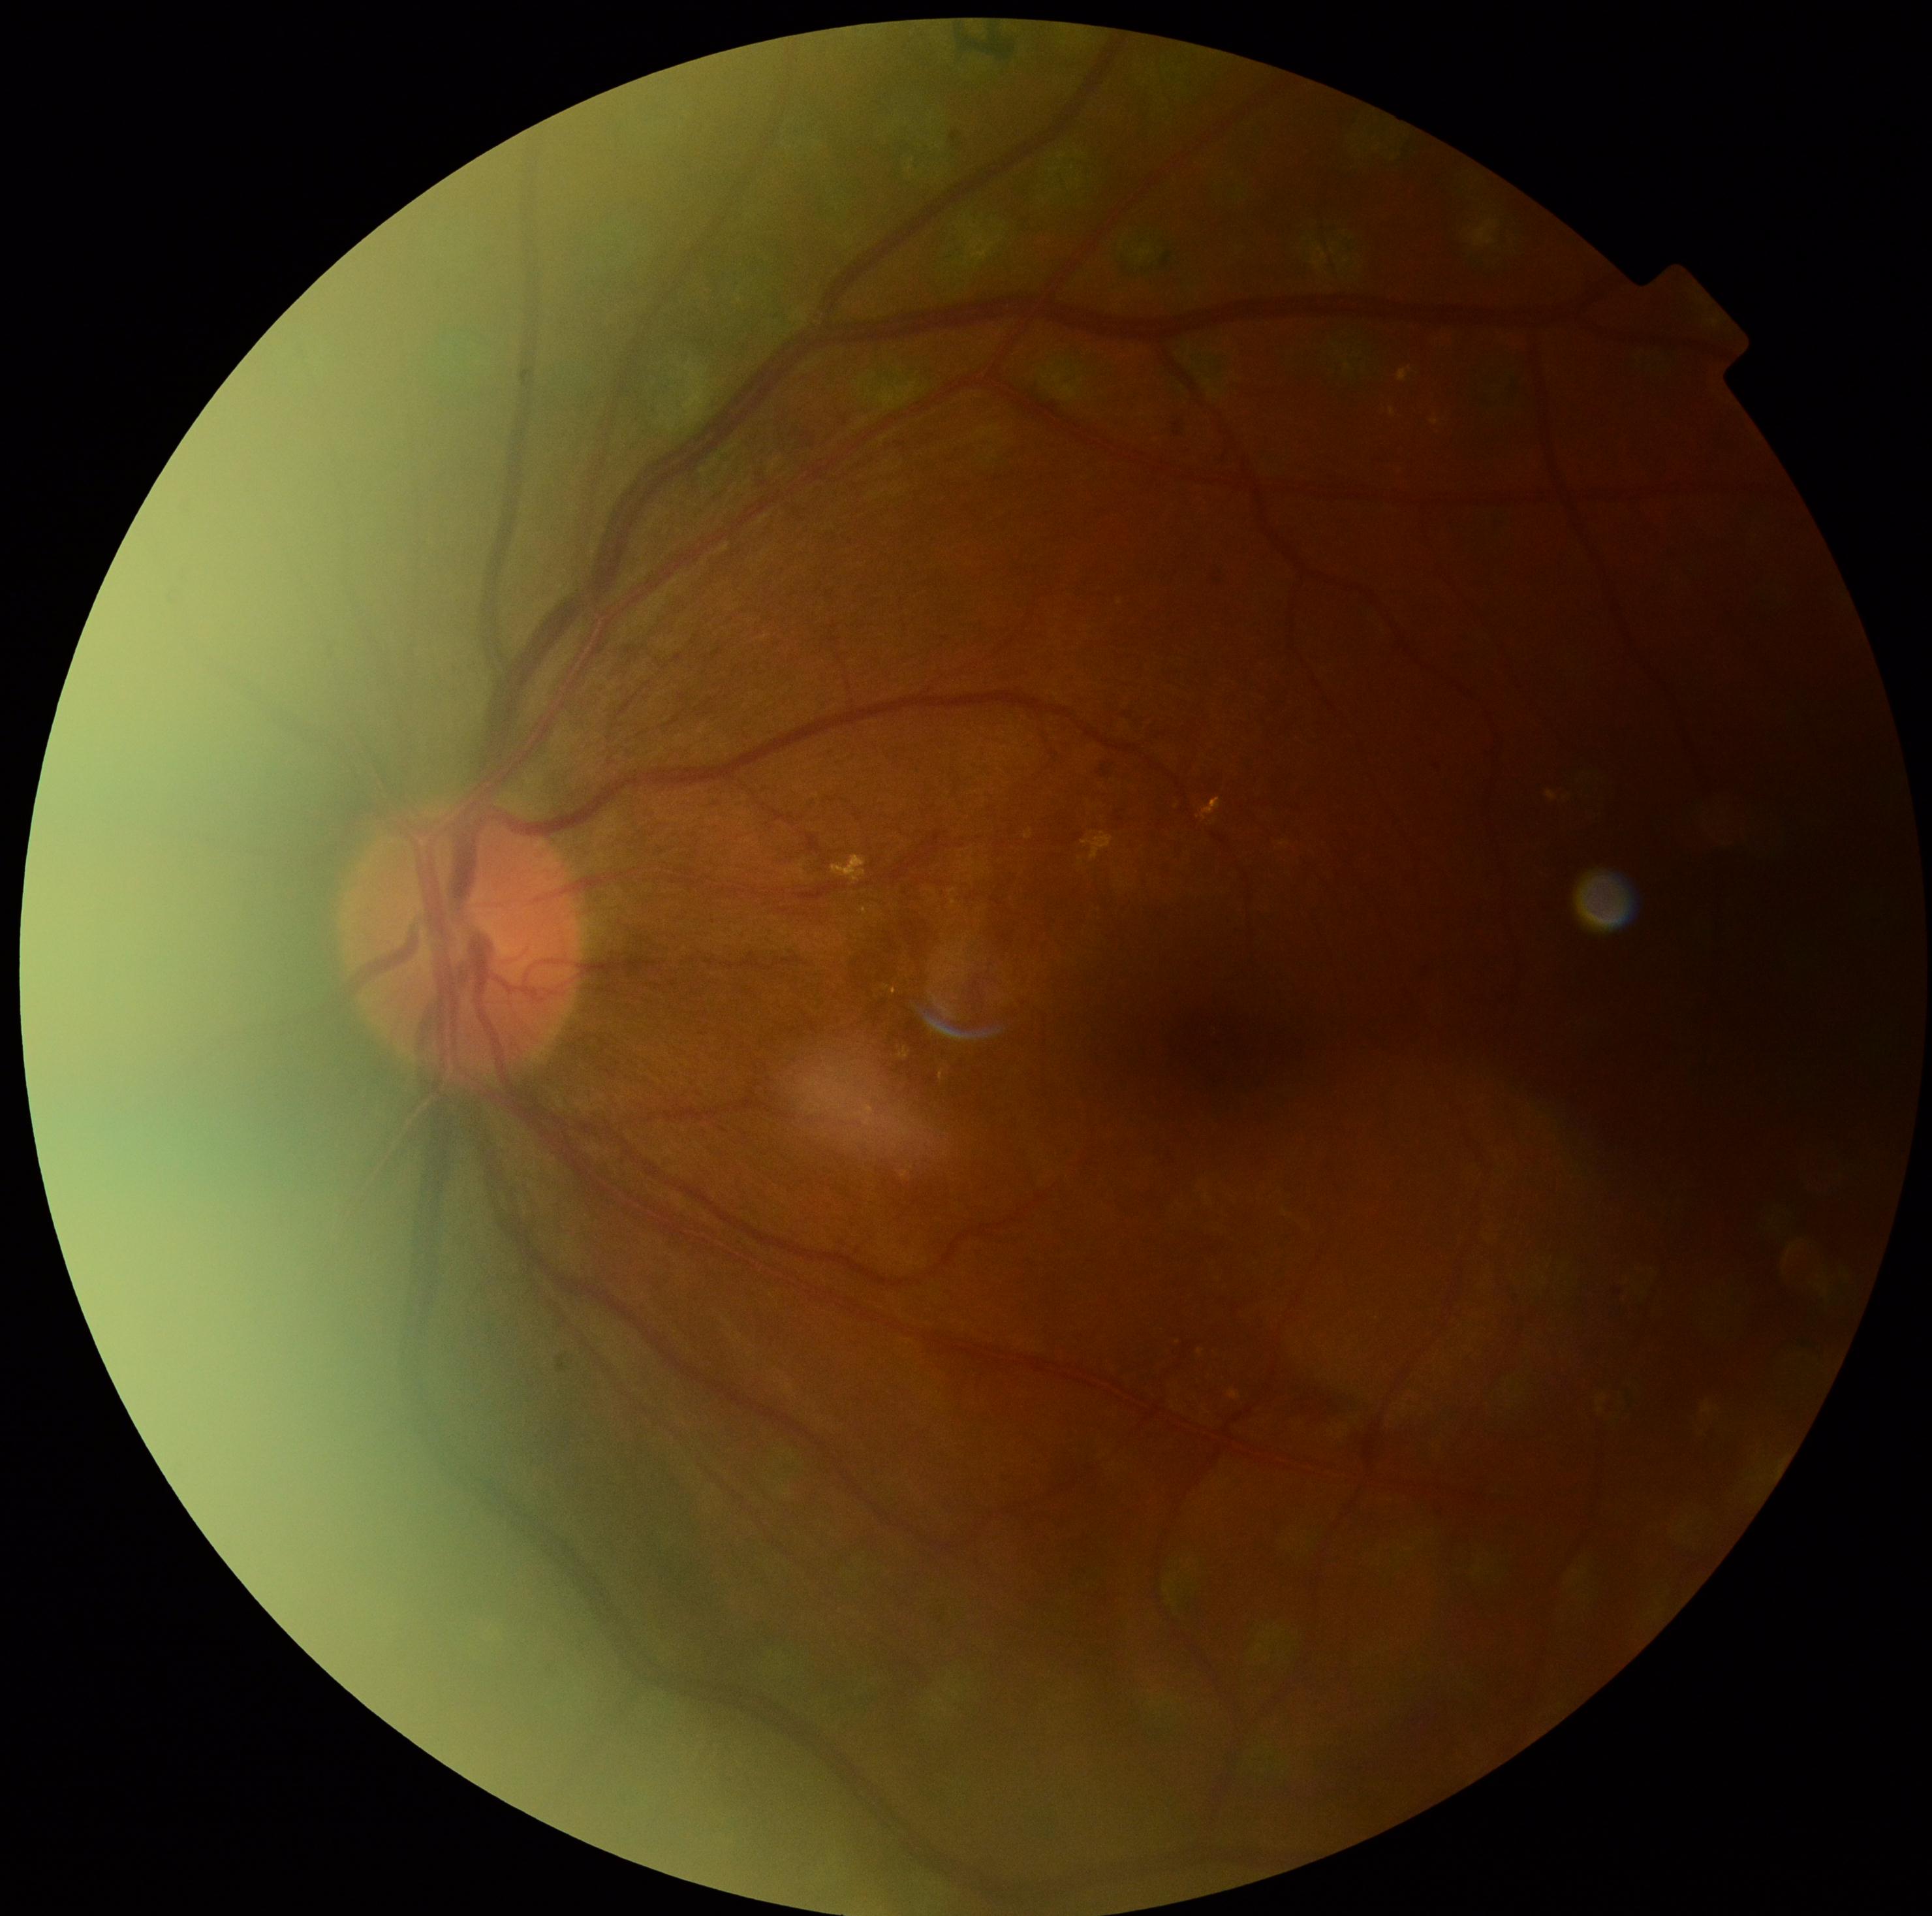 Diabetic retinopathy severity: moderate NPDR (grade 2).